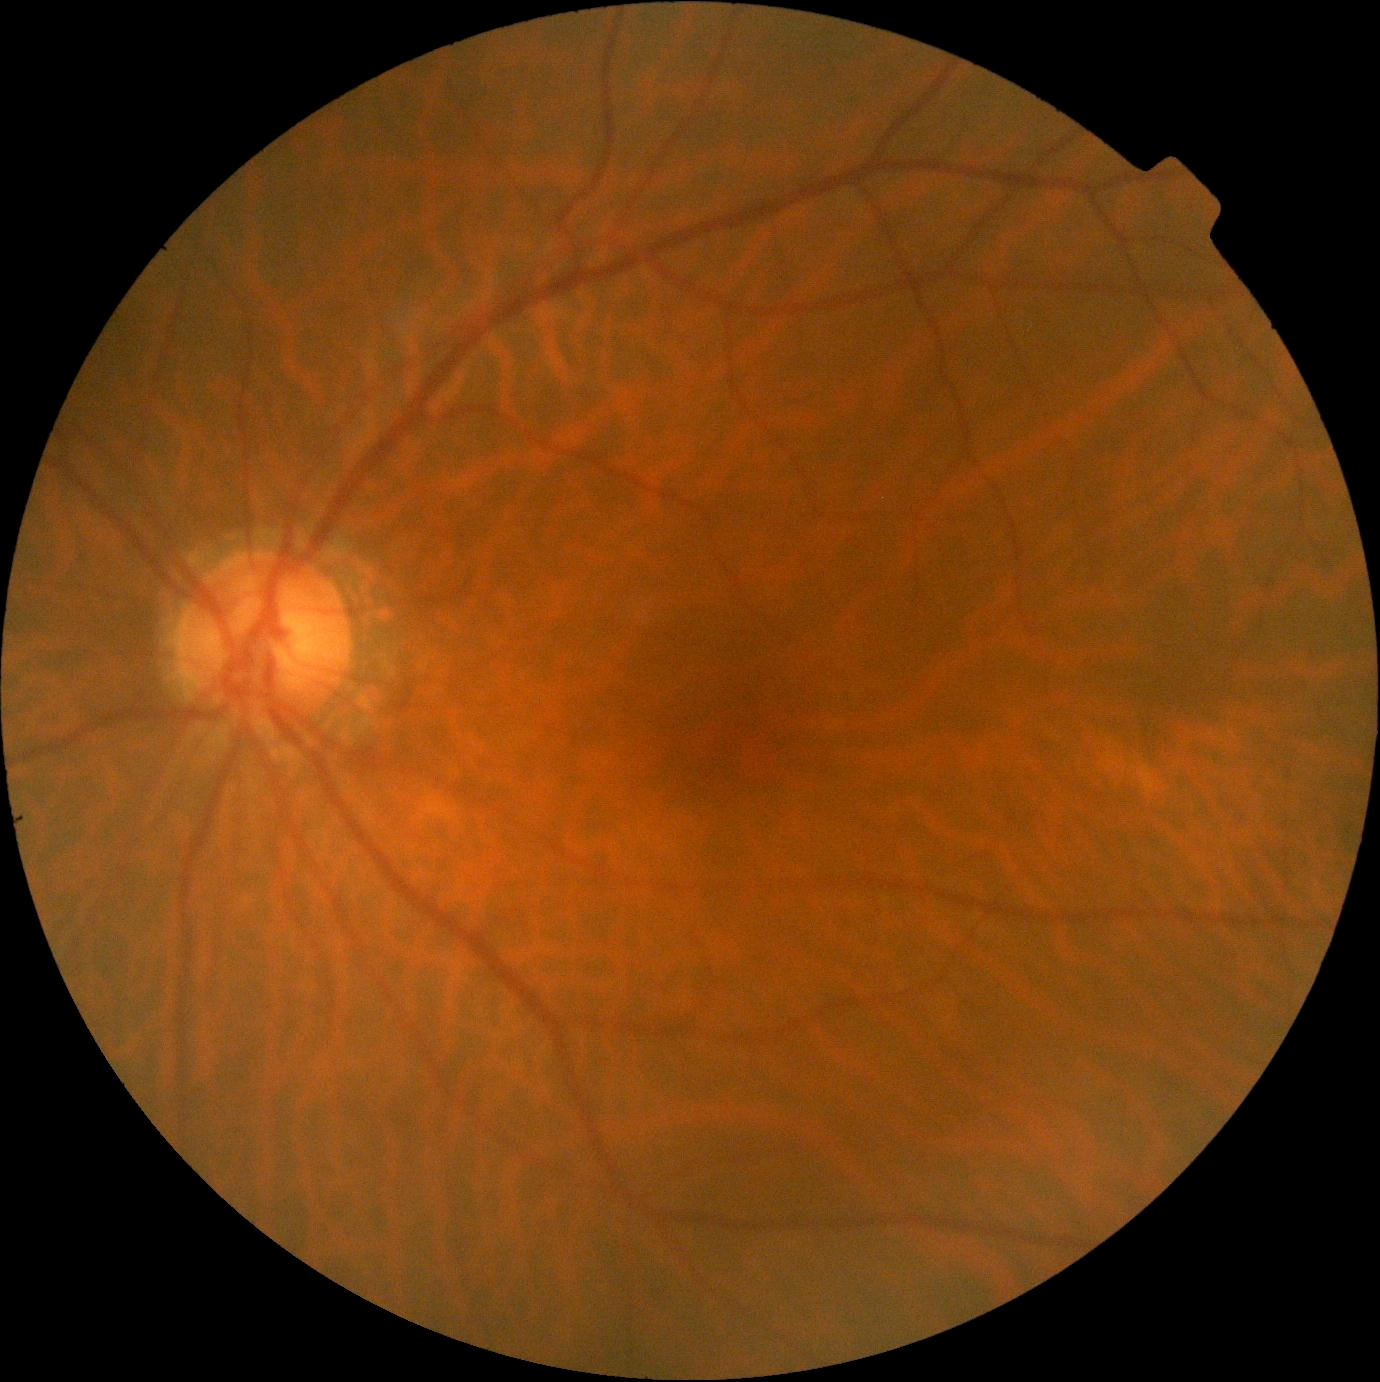

DR impression: no signs of DR, retinopathy: no apparent retinopathy (grade 0).